2352x1568px · 45° FOV · CFP: 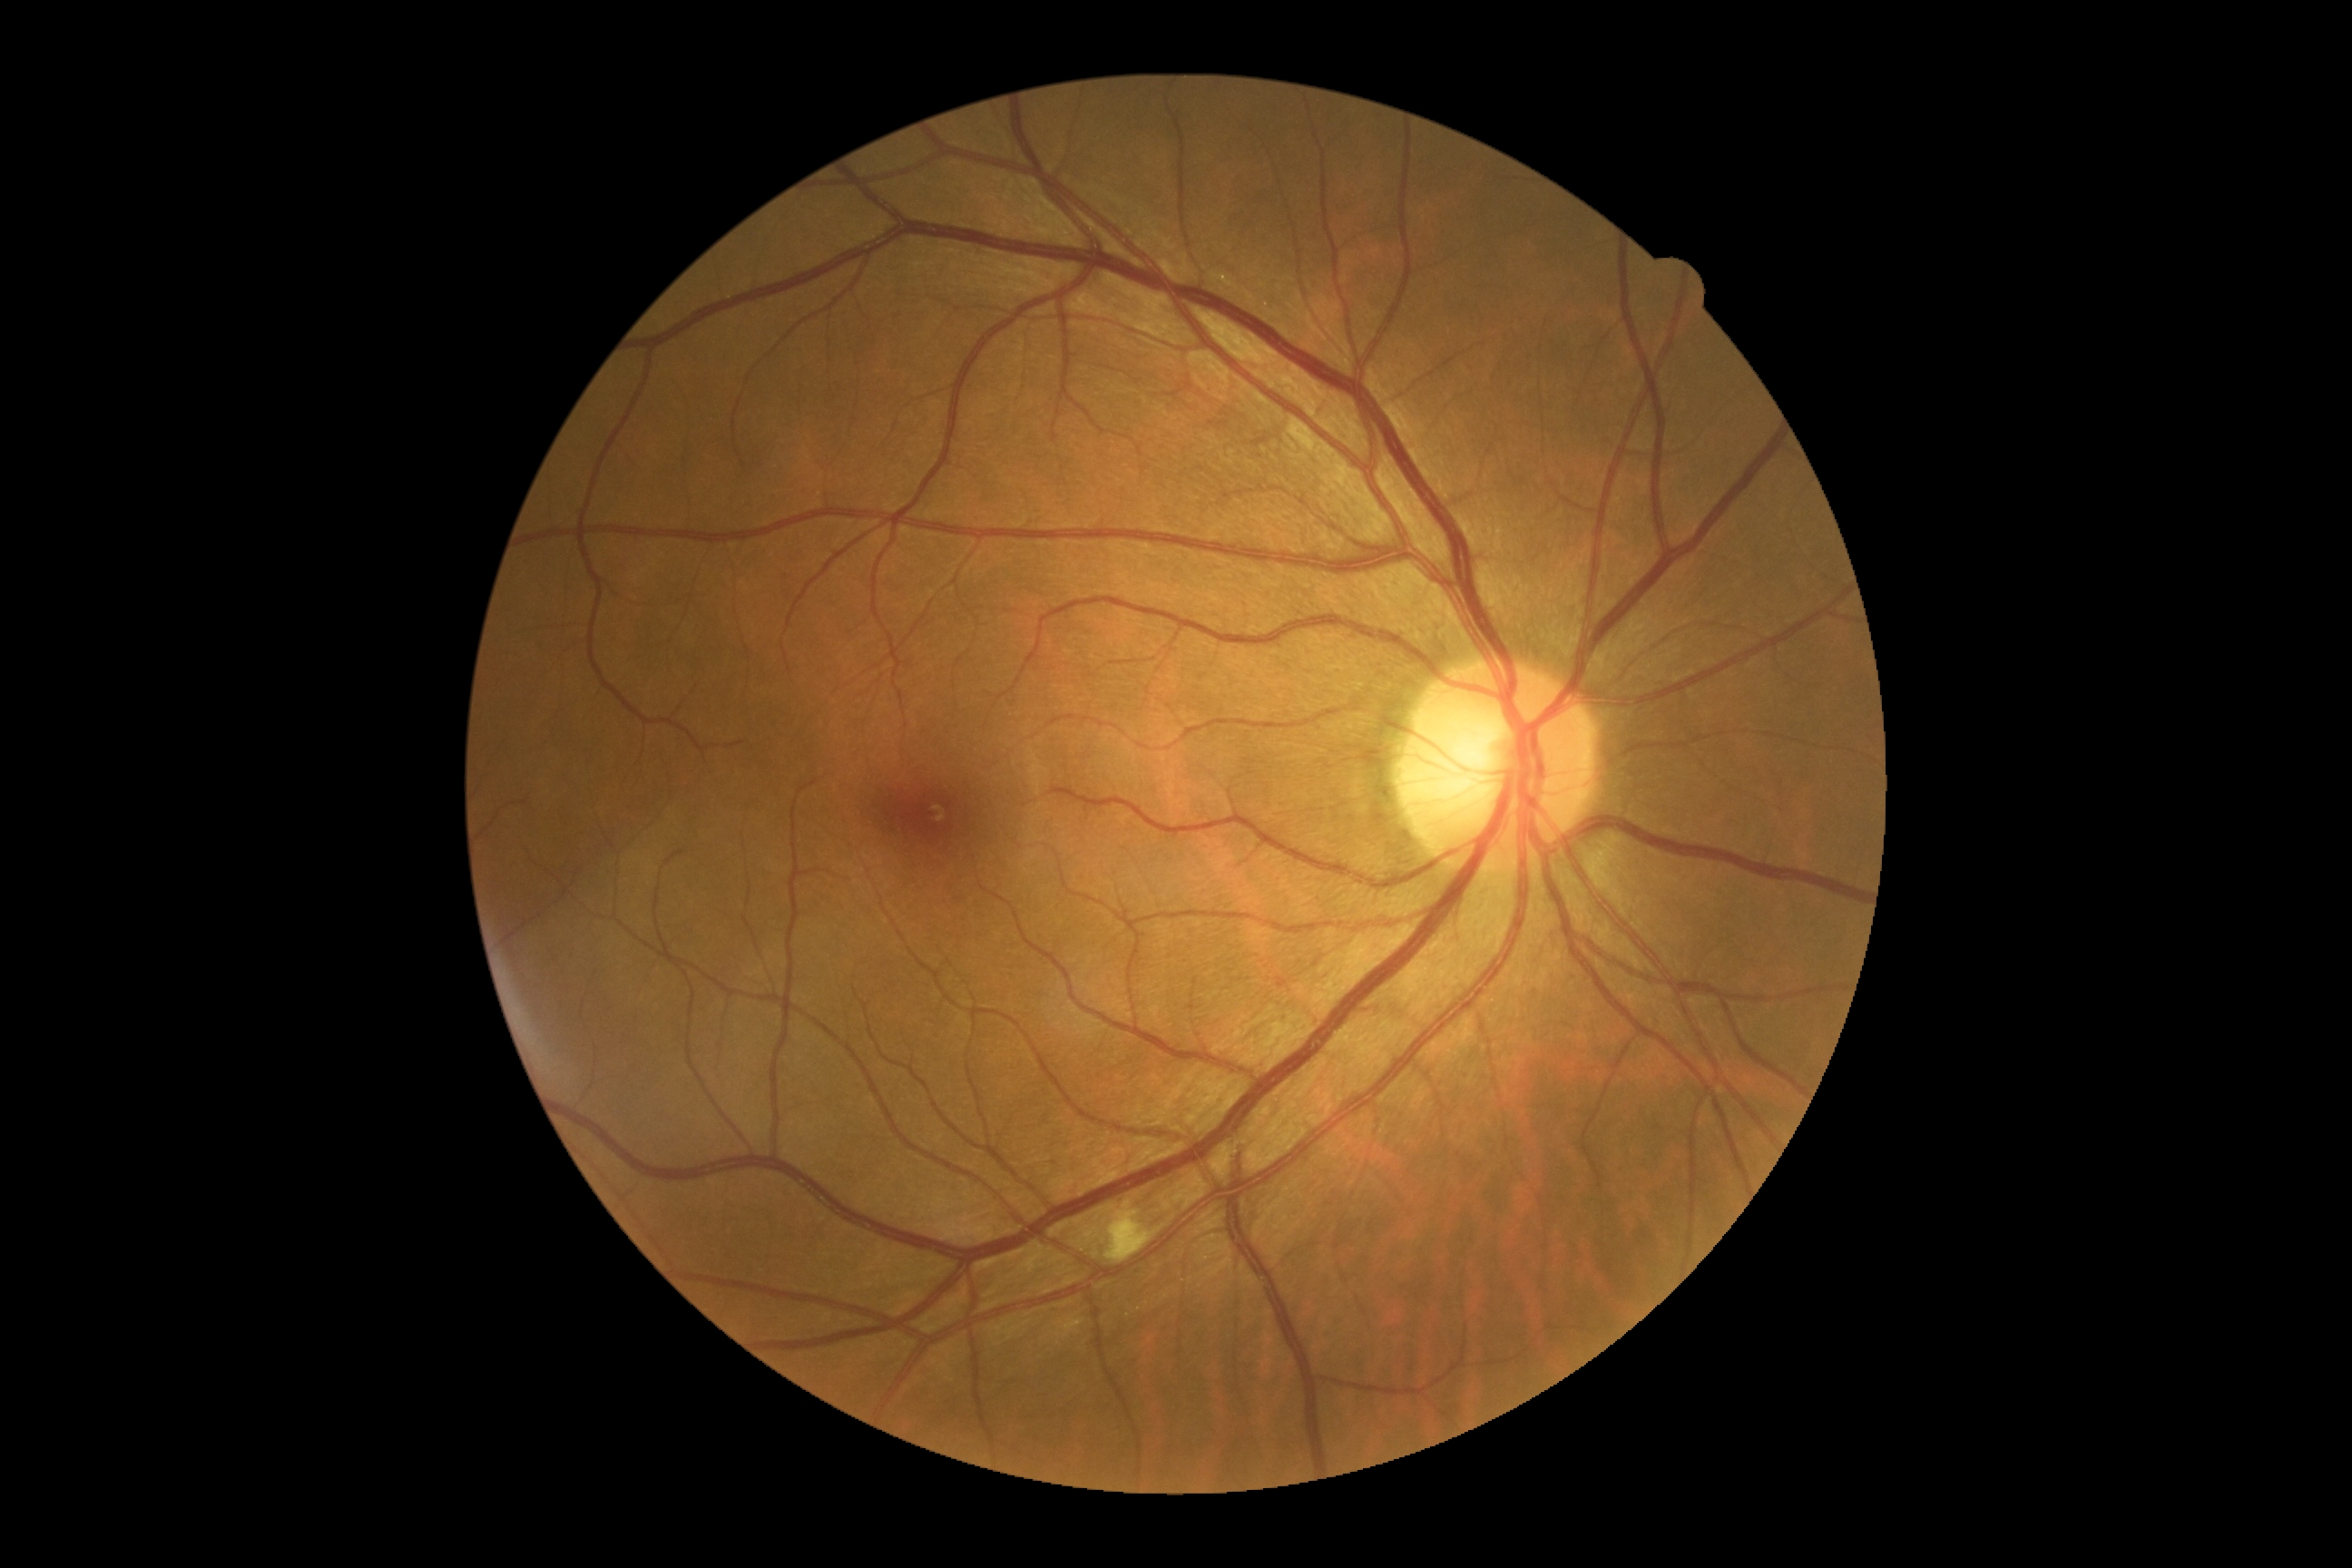

dr_grade: grade 2 (moderate NPDR)